2352x1568, FOV: 45 degrees
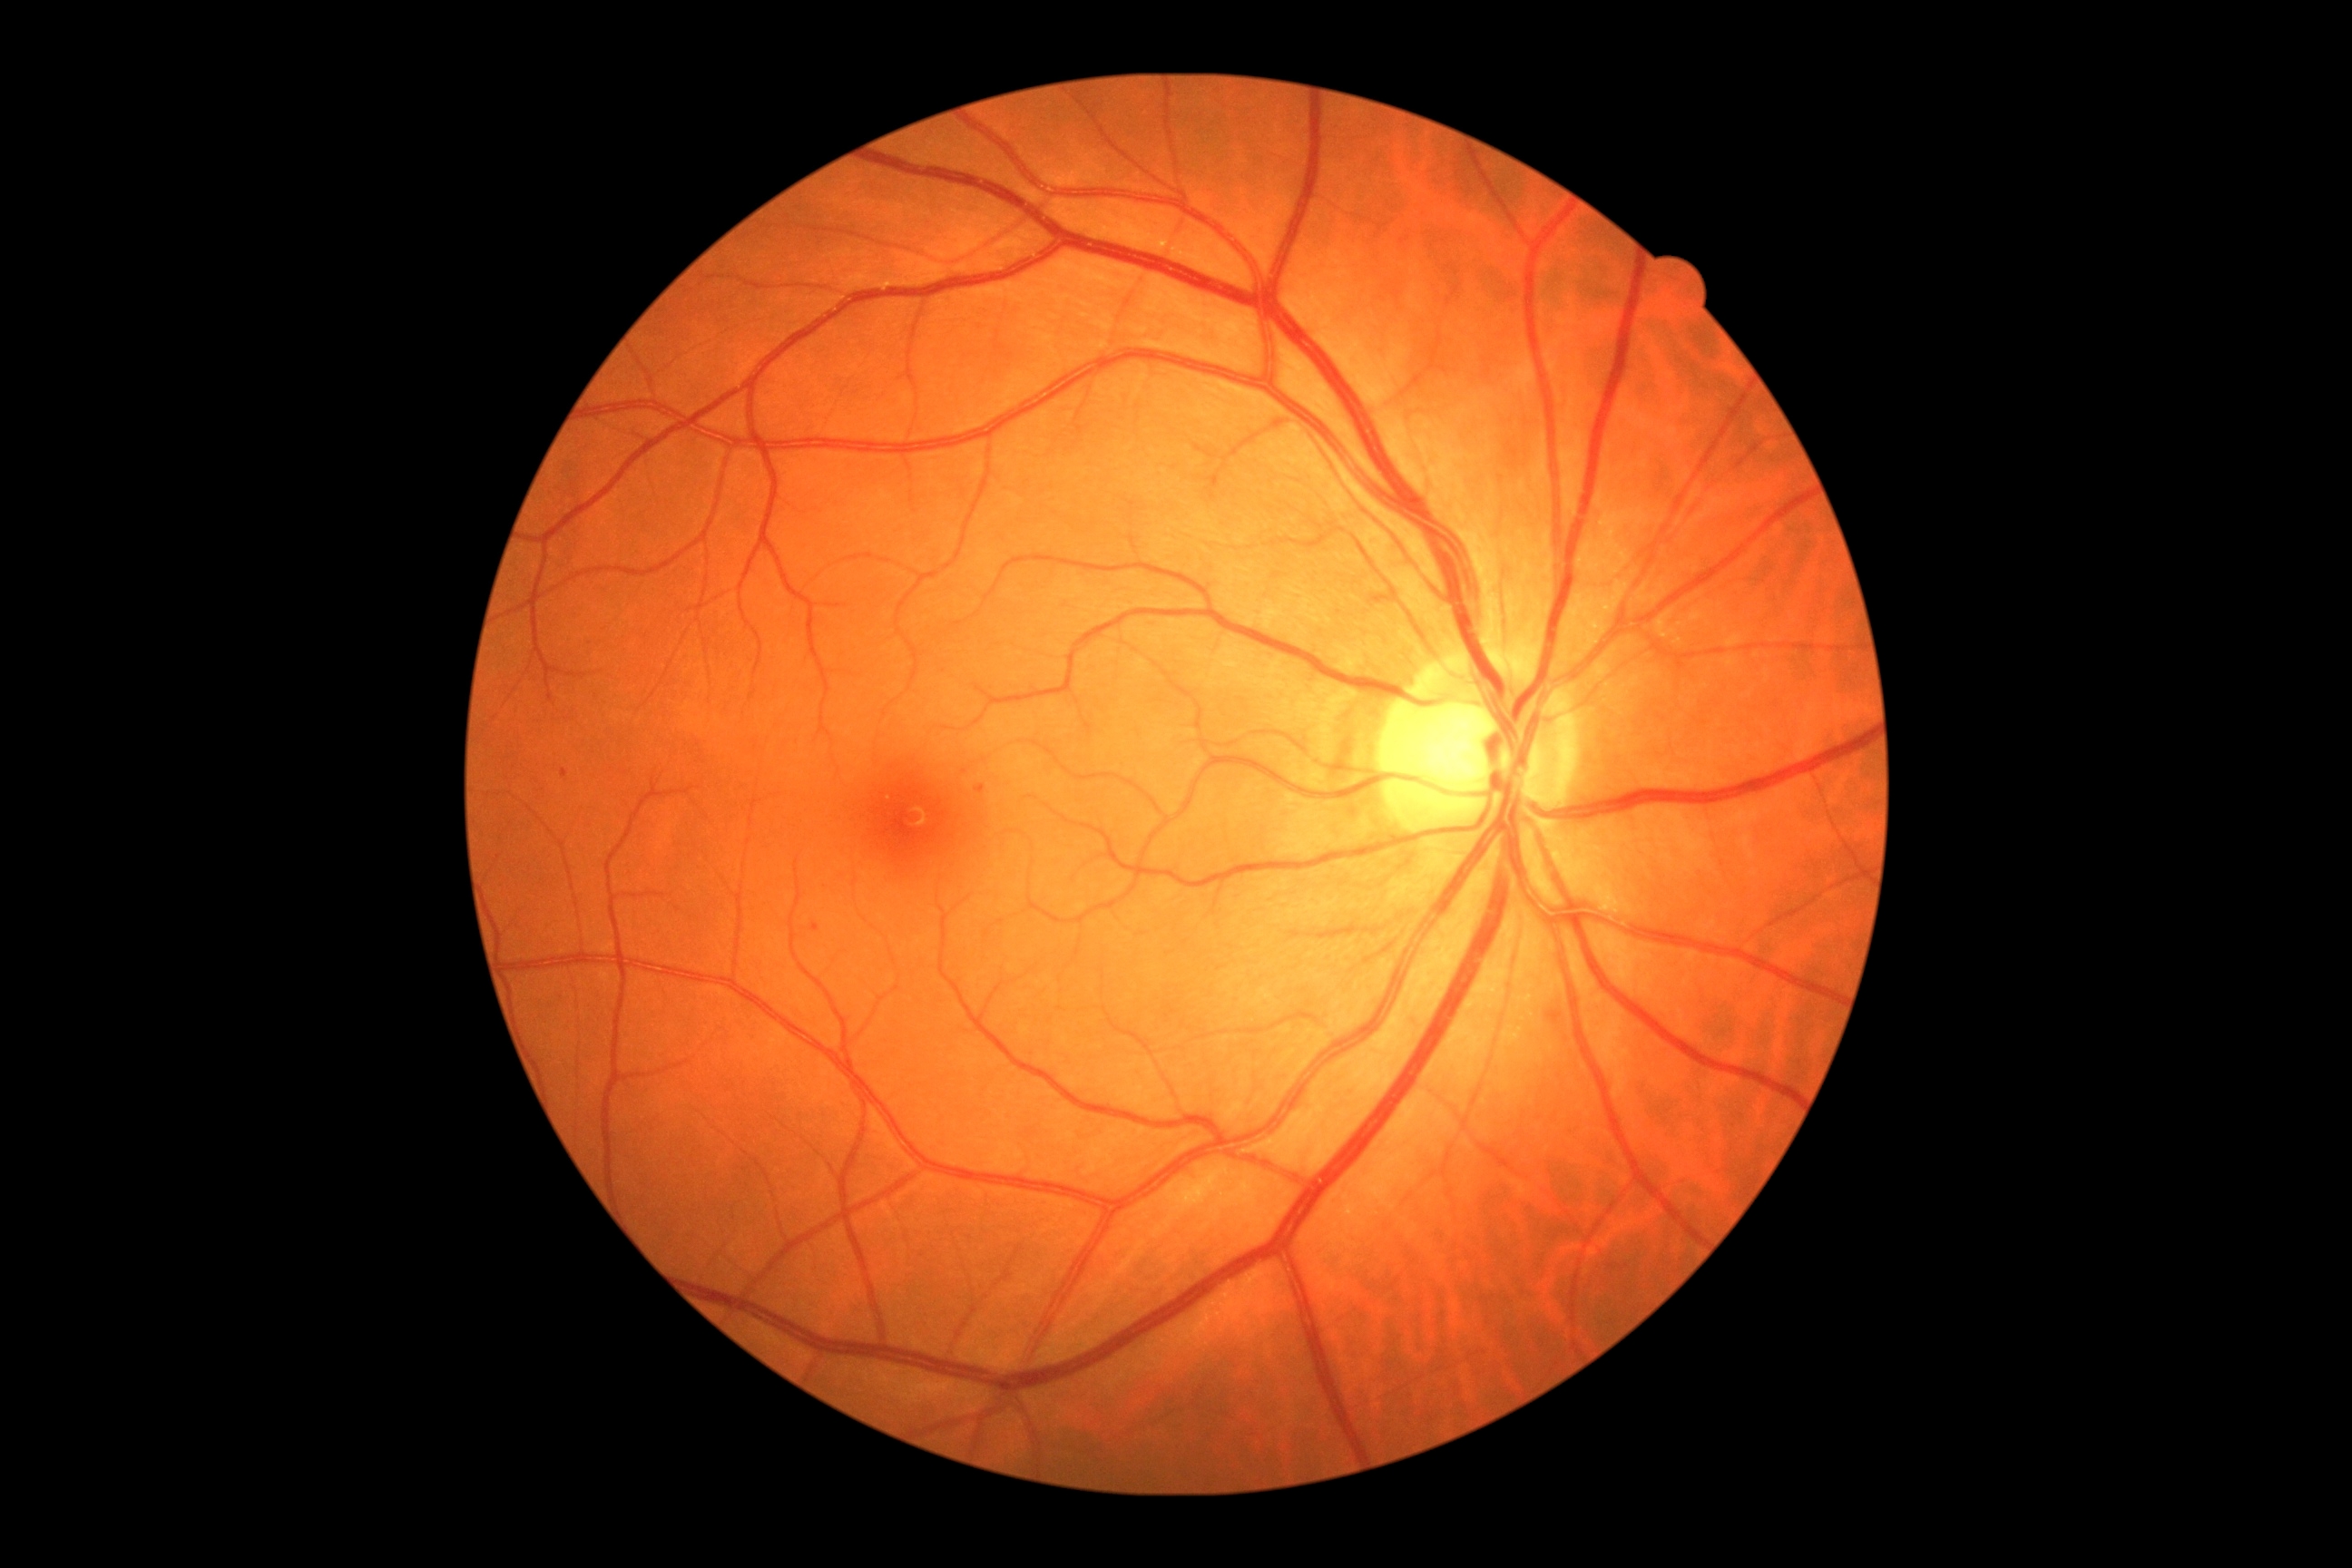

retinopathy = 1/4.